Retinal fundus photograph · 512x512px: 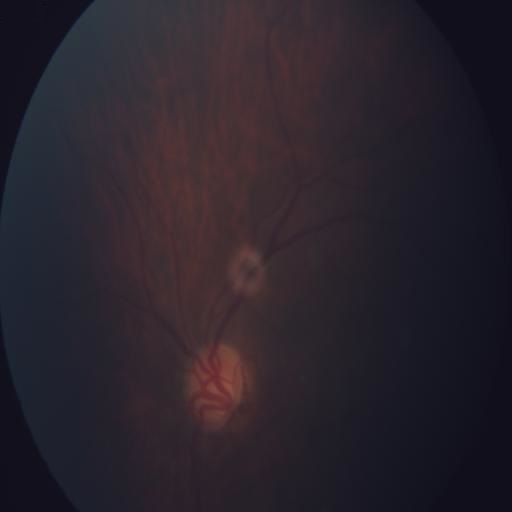
Impression: tilted disc.